Graded on the modified Davis scale:
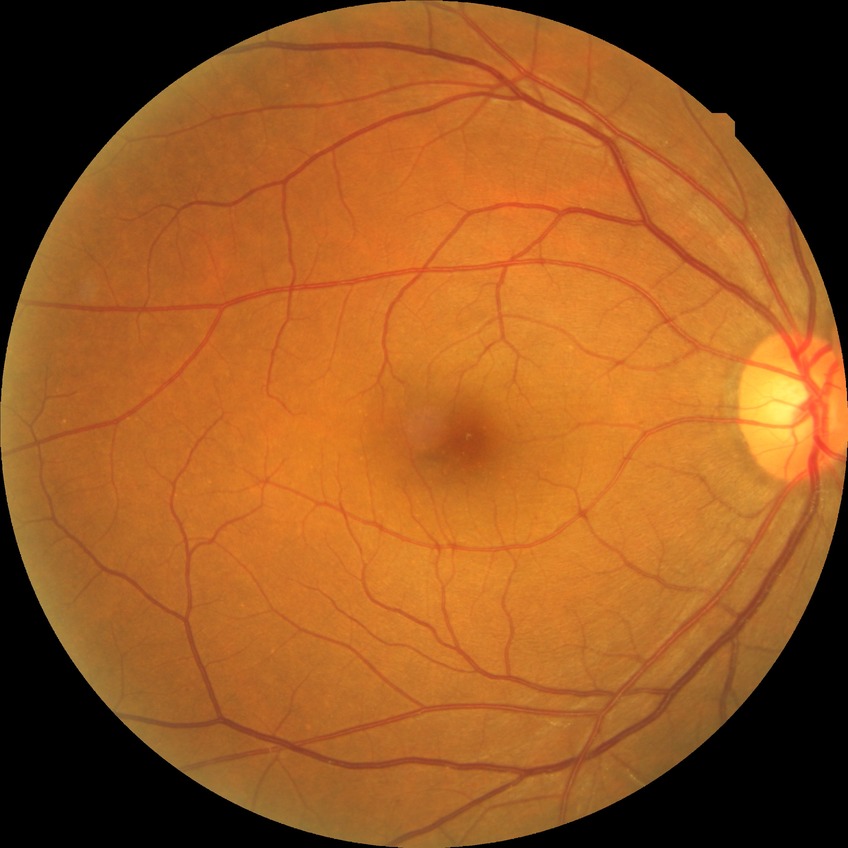
Davis grade = NDR; DR impression = no apparent DR.